45° FOV.
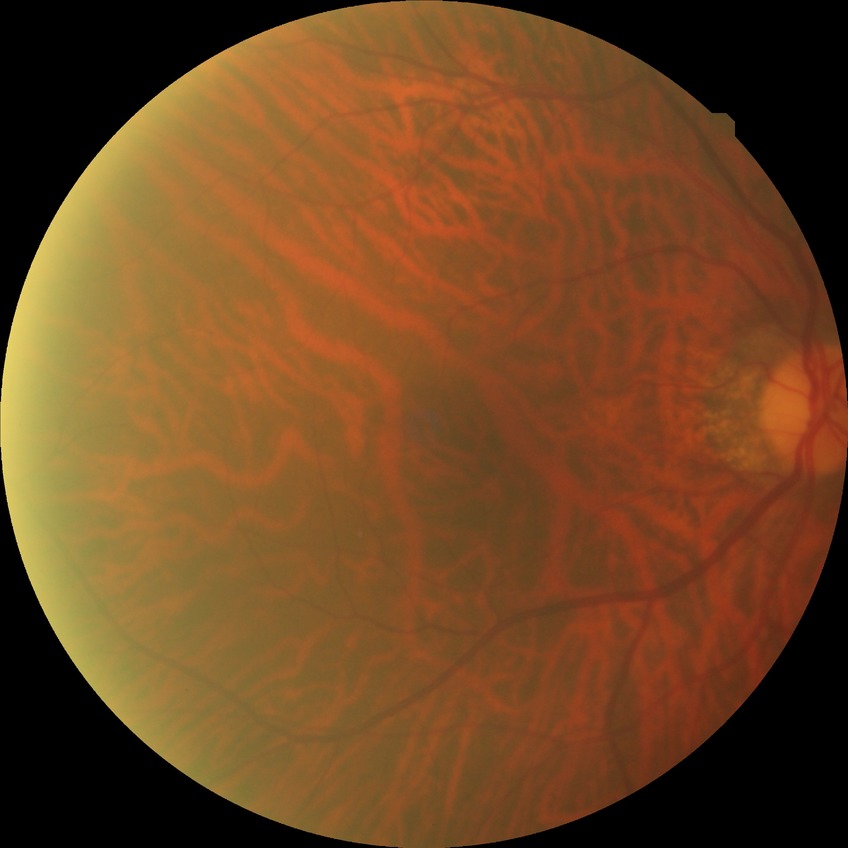 DR severity=NDR.